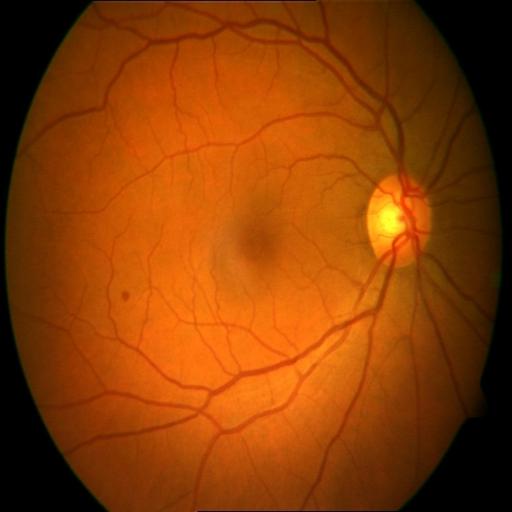

Impression (2): CME (cystoid macular edema), HR (hemorrhagic retinopathy).